45° FOV: 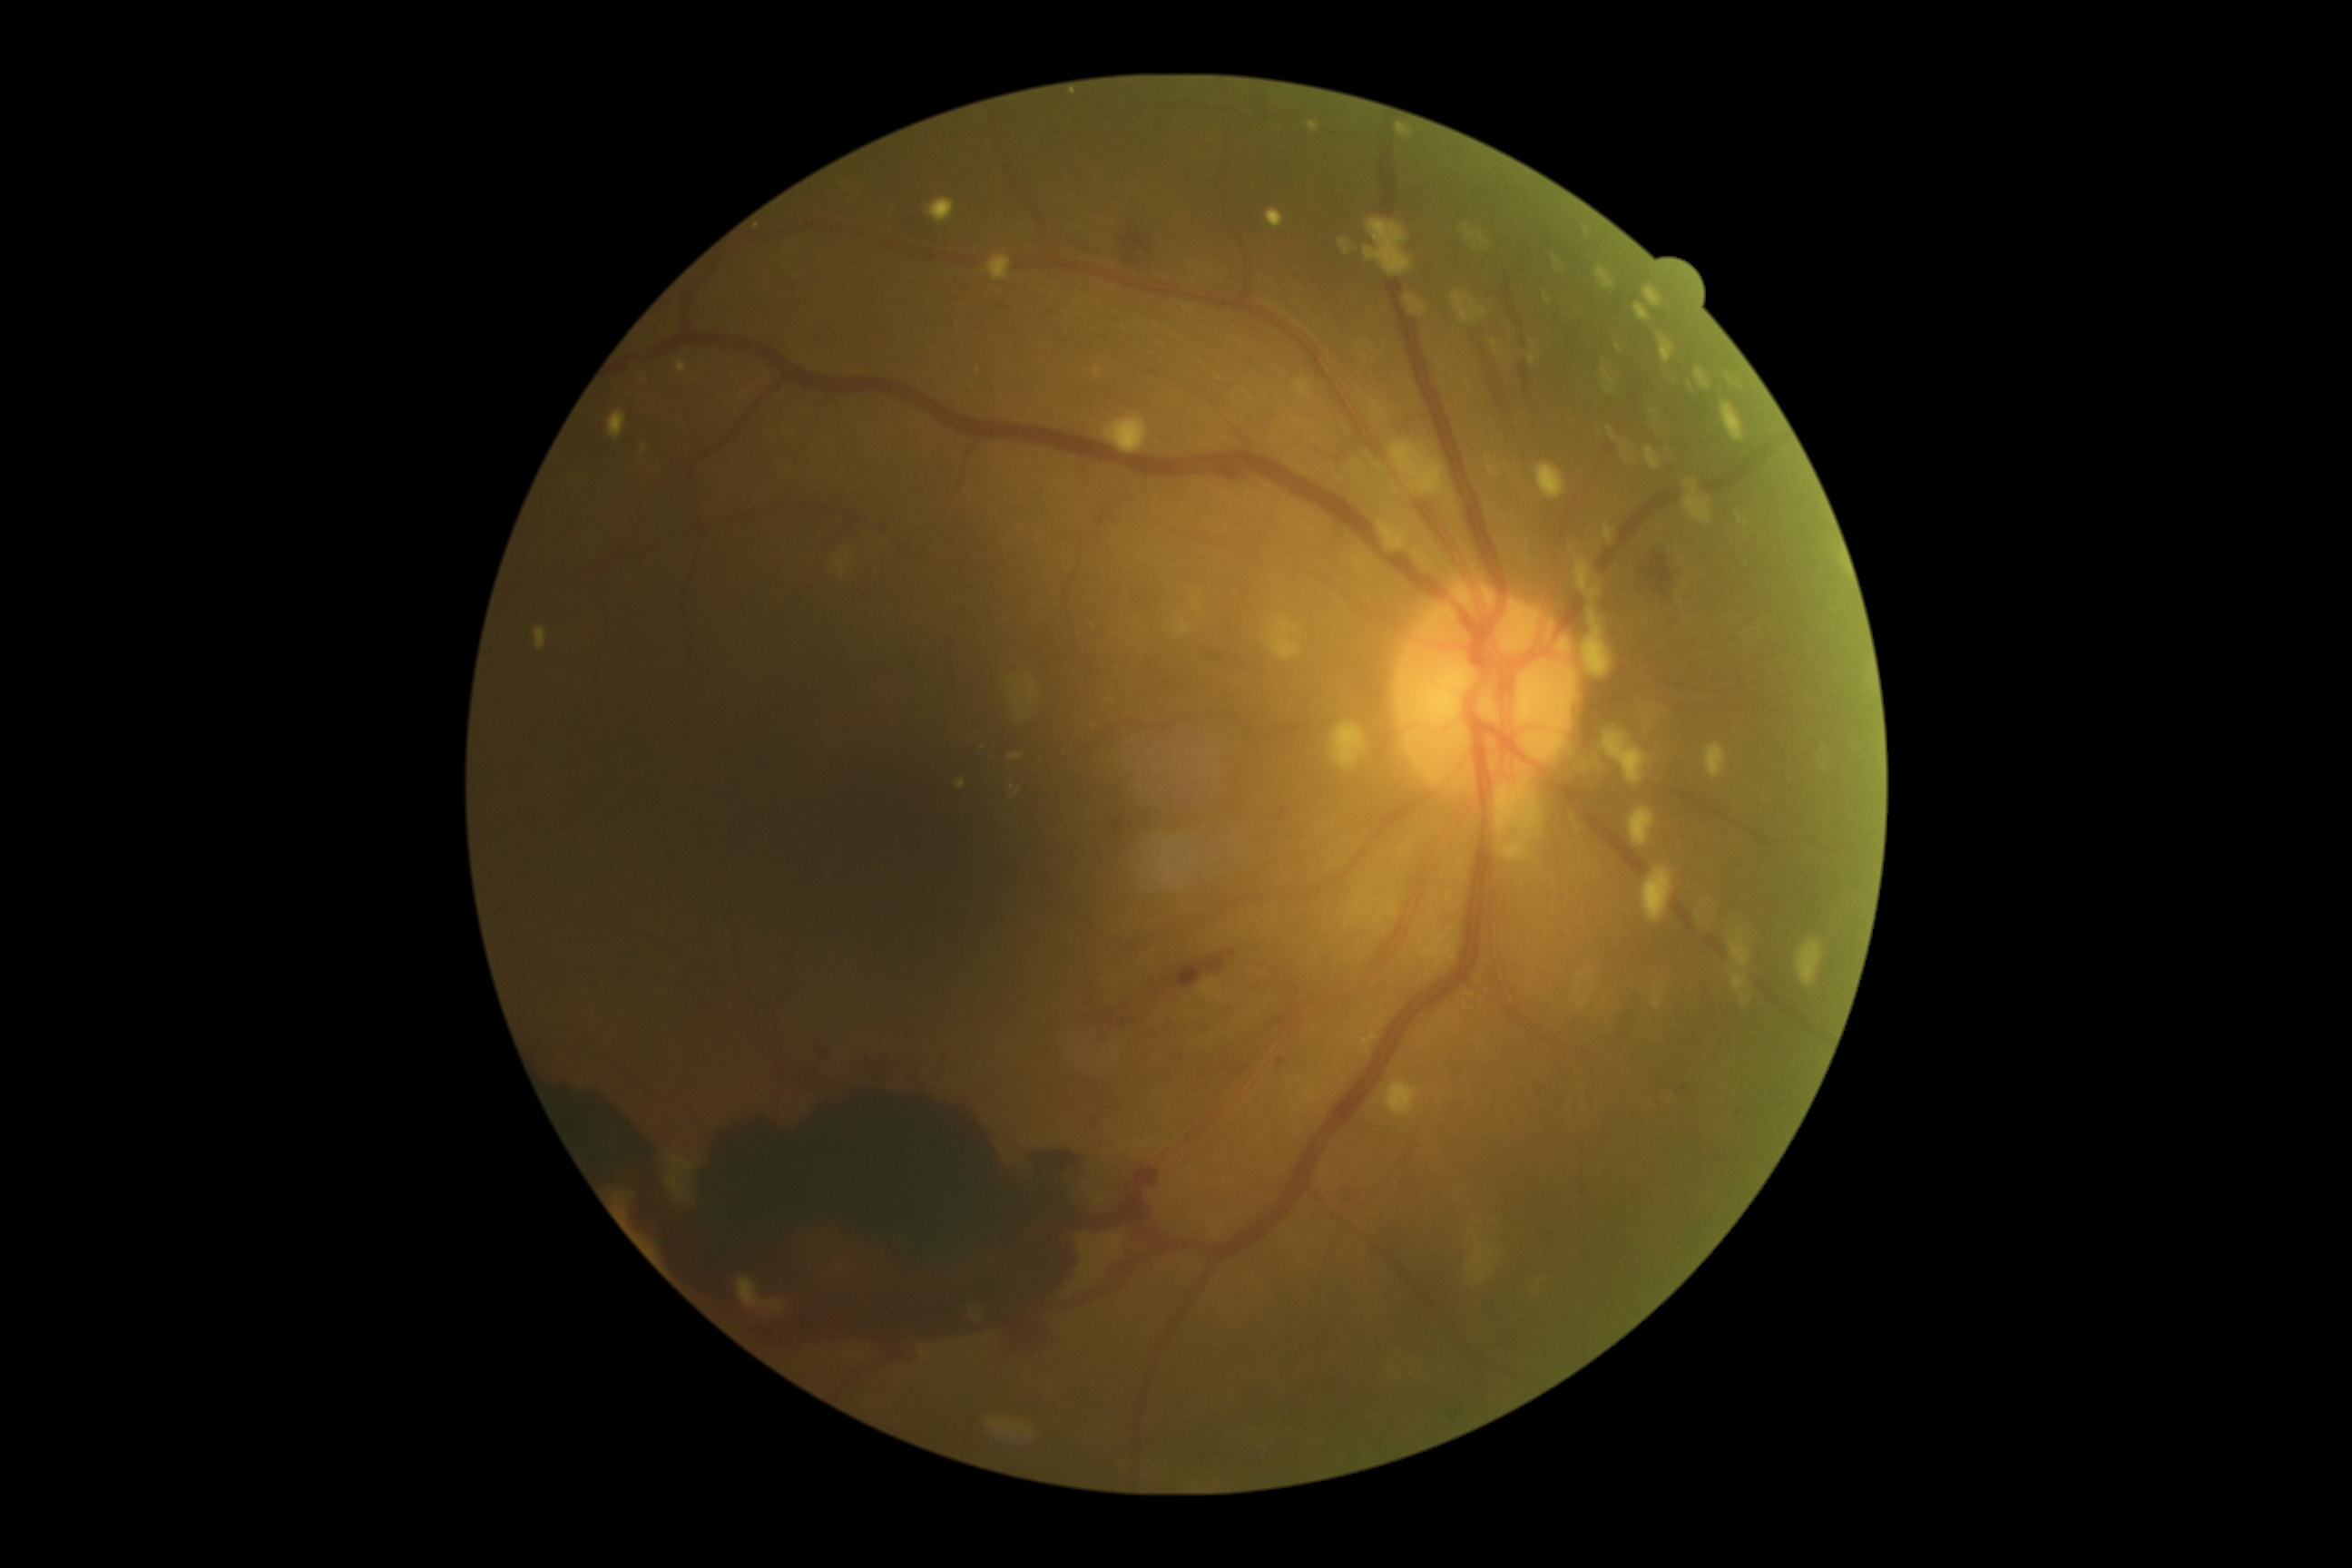 {
  "dr_grade": "4"
}